640x480px; wide-field fundus photograph from neonatal ROP screening: 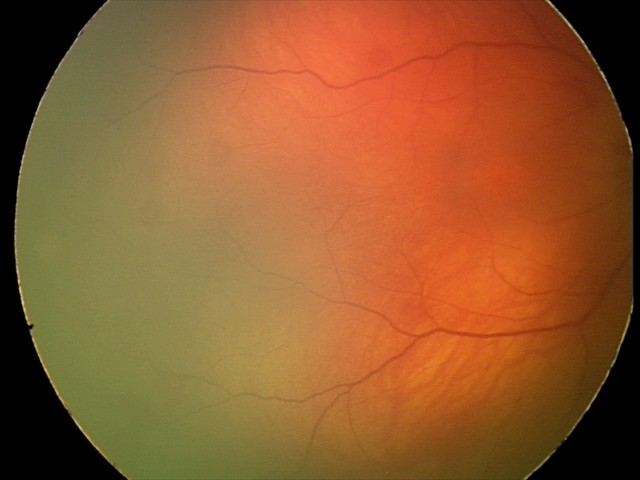
Screening series with retinal hemorrhages.